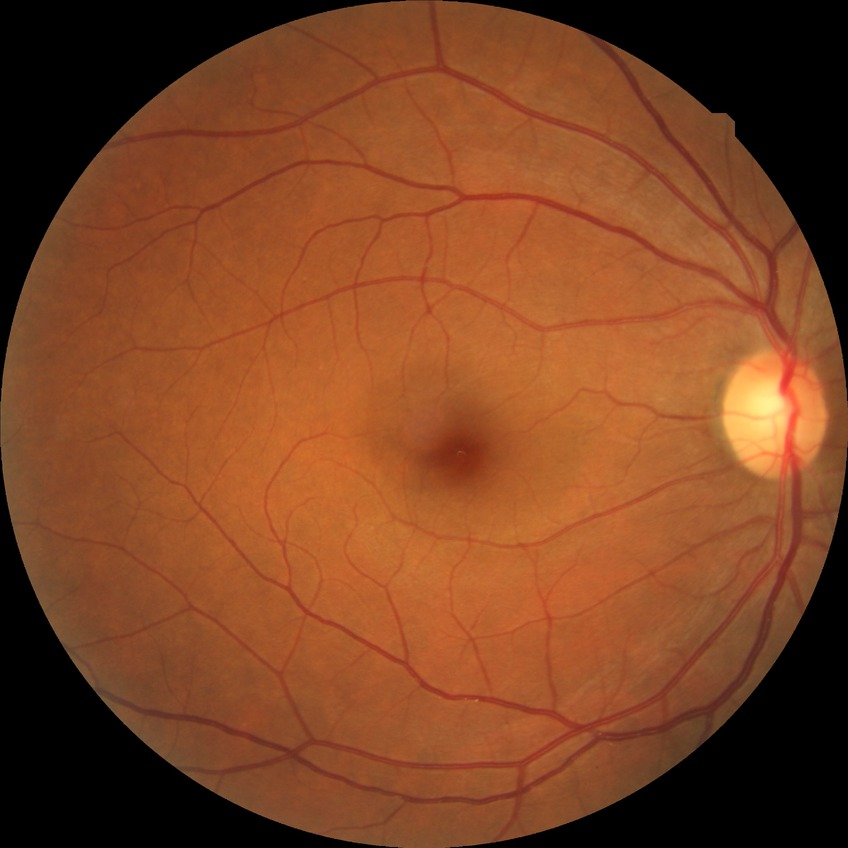

Diabetic retinopathy (DR) is no diabetic retinopathy (NDR).